Modified Davis grading
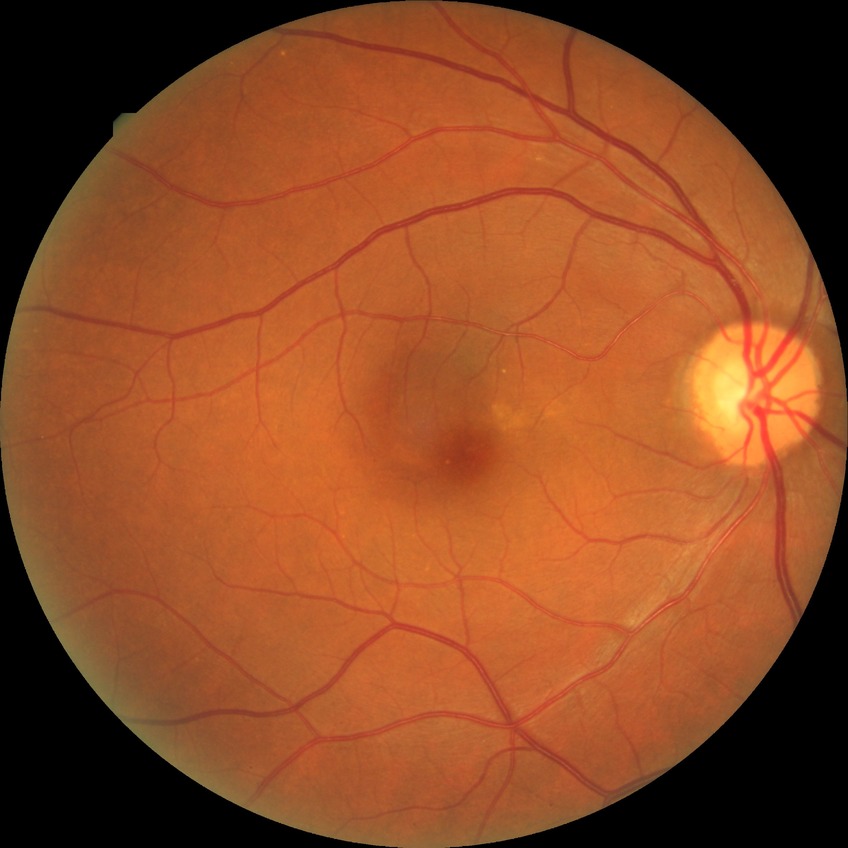 diabetic retinopathy (DR)=NDR (no diabetic retinopathy).